CFP
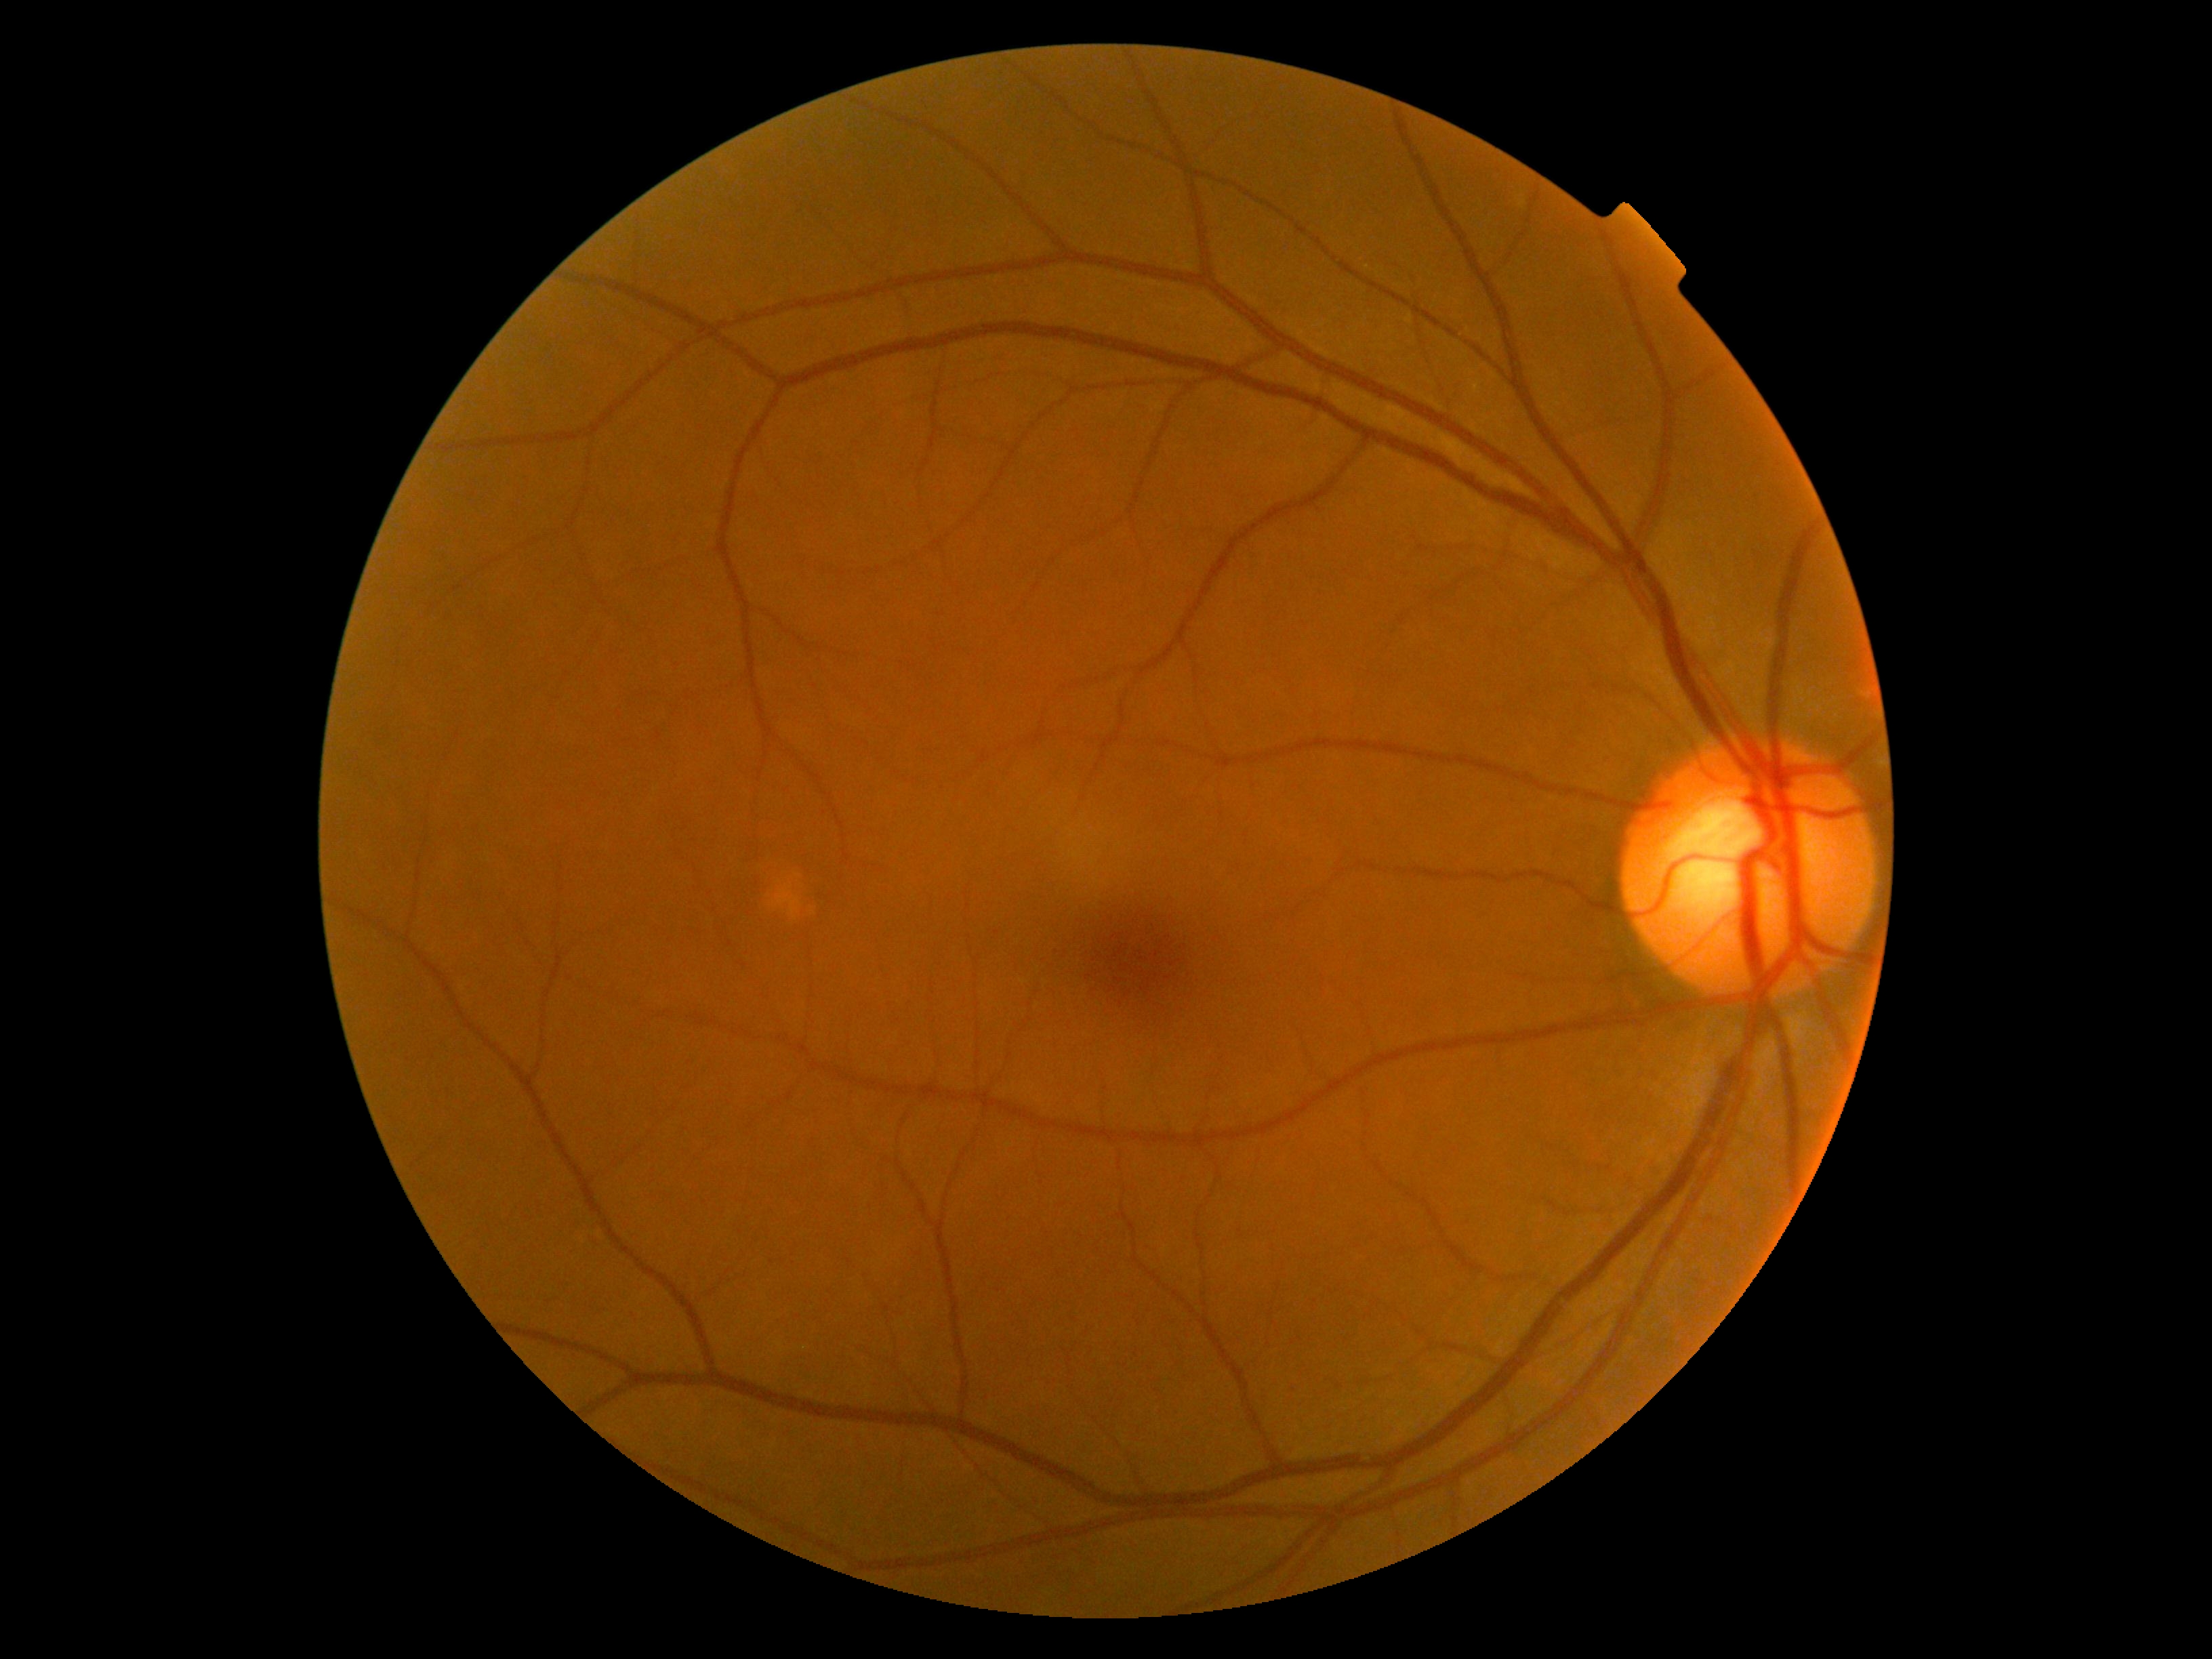

Diabetic retinopathy (DR) is no apparent diabetic retinopathy (grade 0).